Image size 848x848; 45° FOV; acquired with a NIDEK AFC-230 — 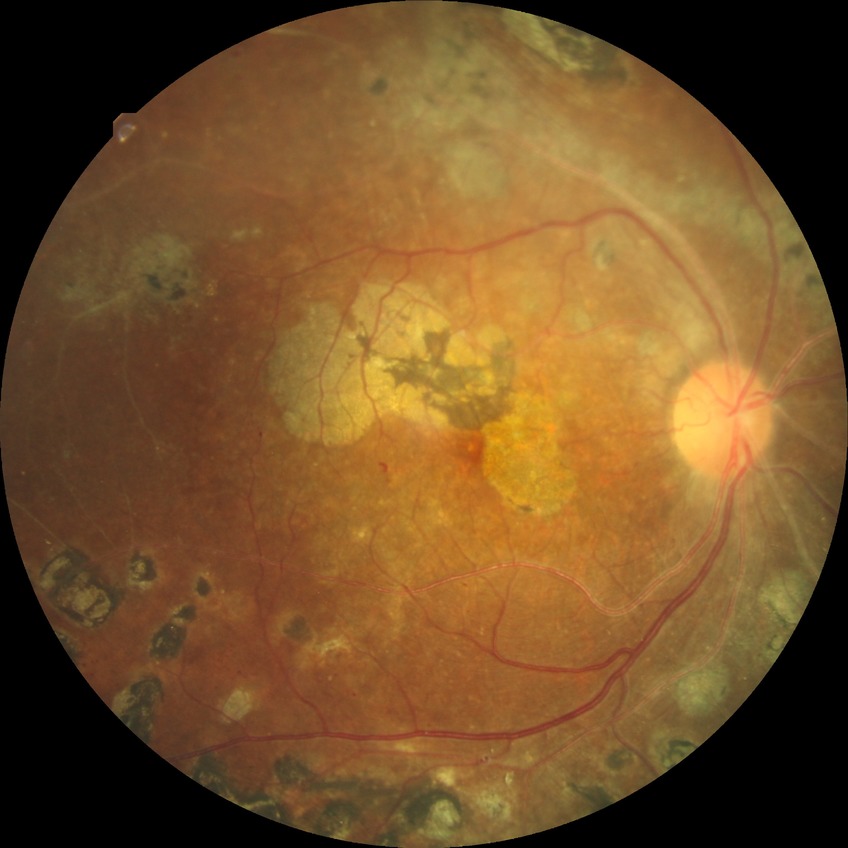 Diabetic retinopathy (DR) is PDR (proliferative diabetic retinopathy).